Mydriatic (tropicamide and phenylephrine)
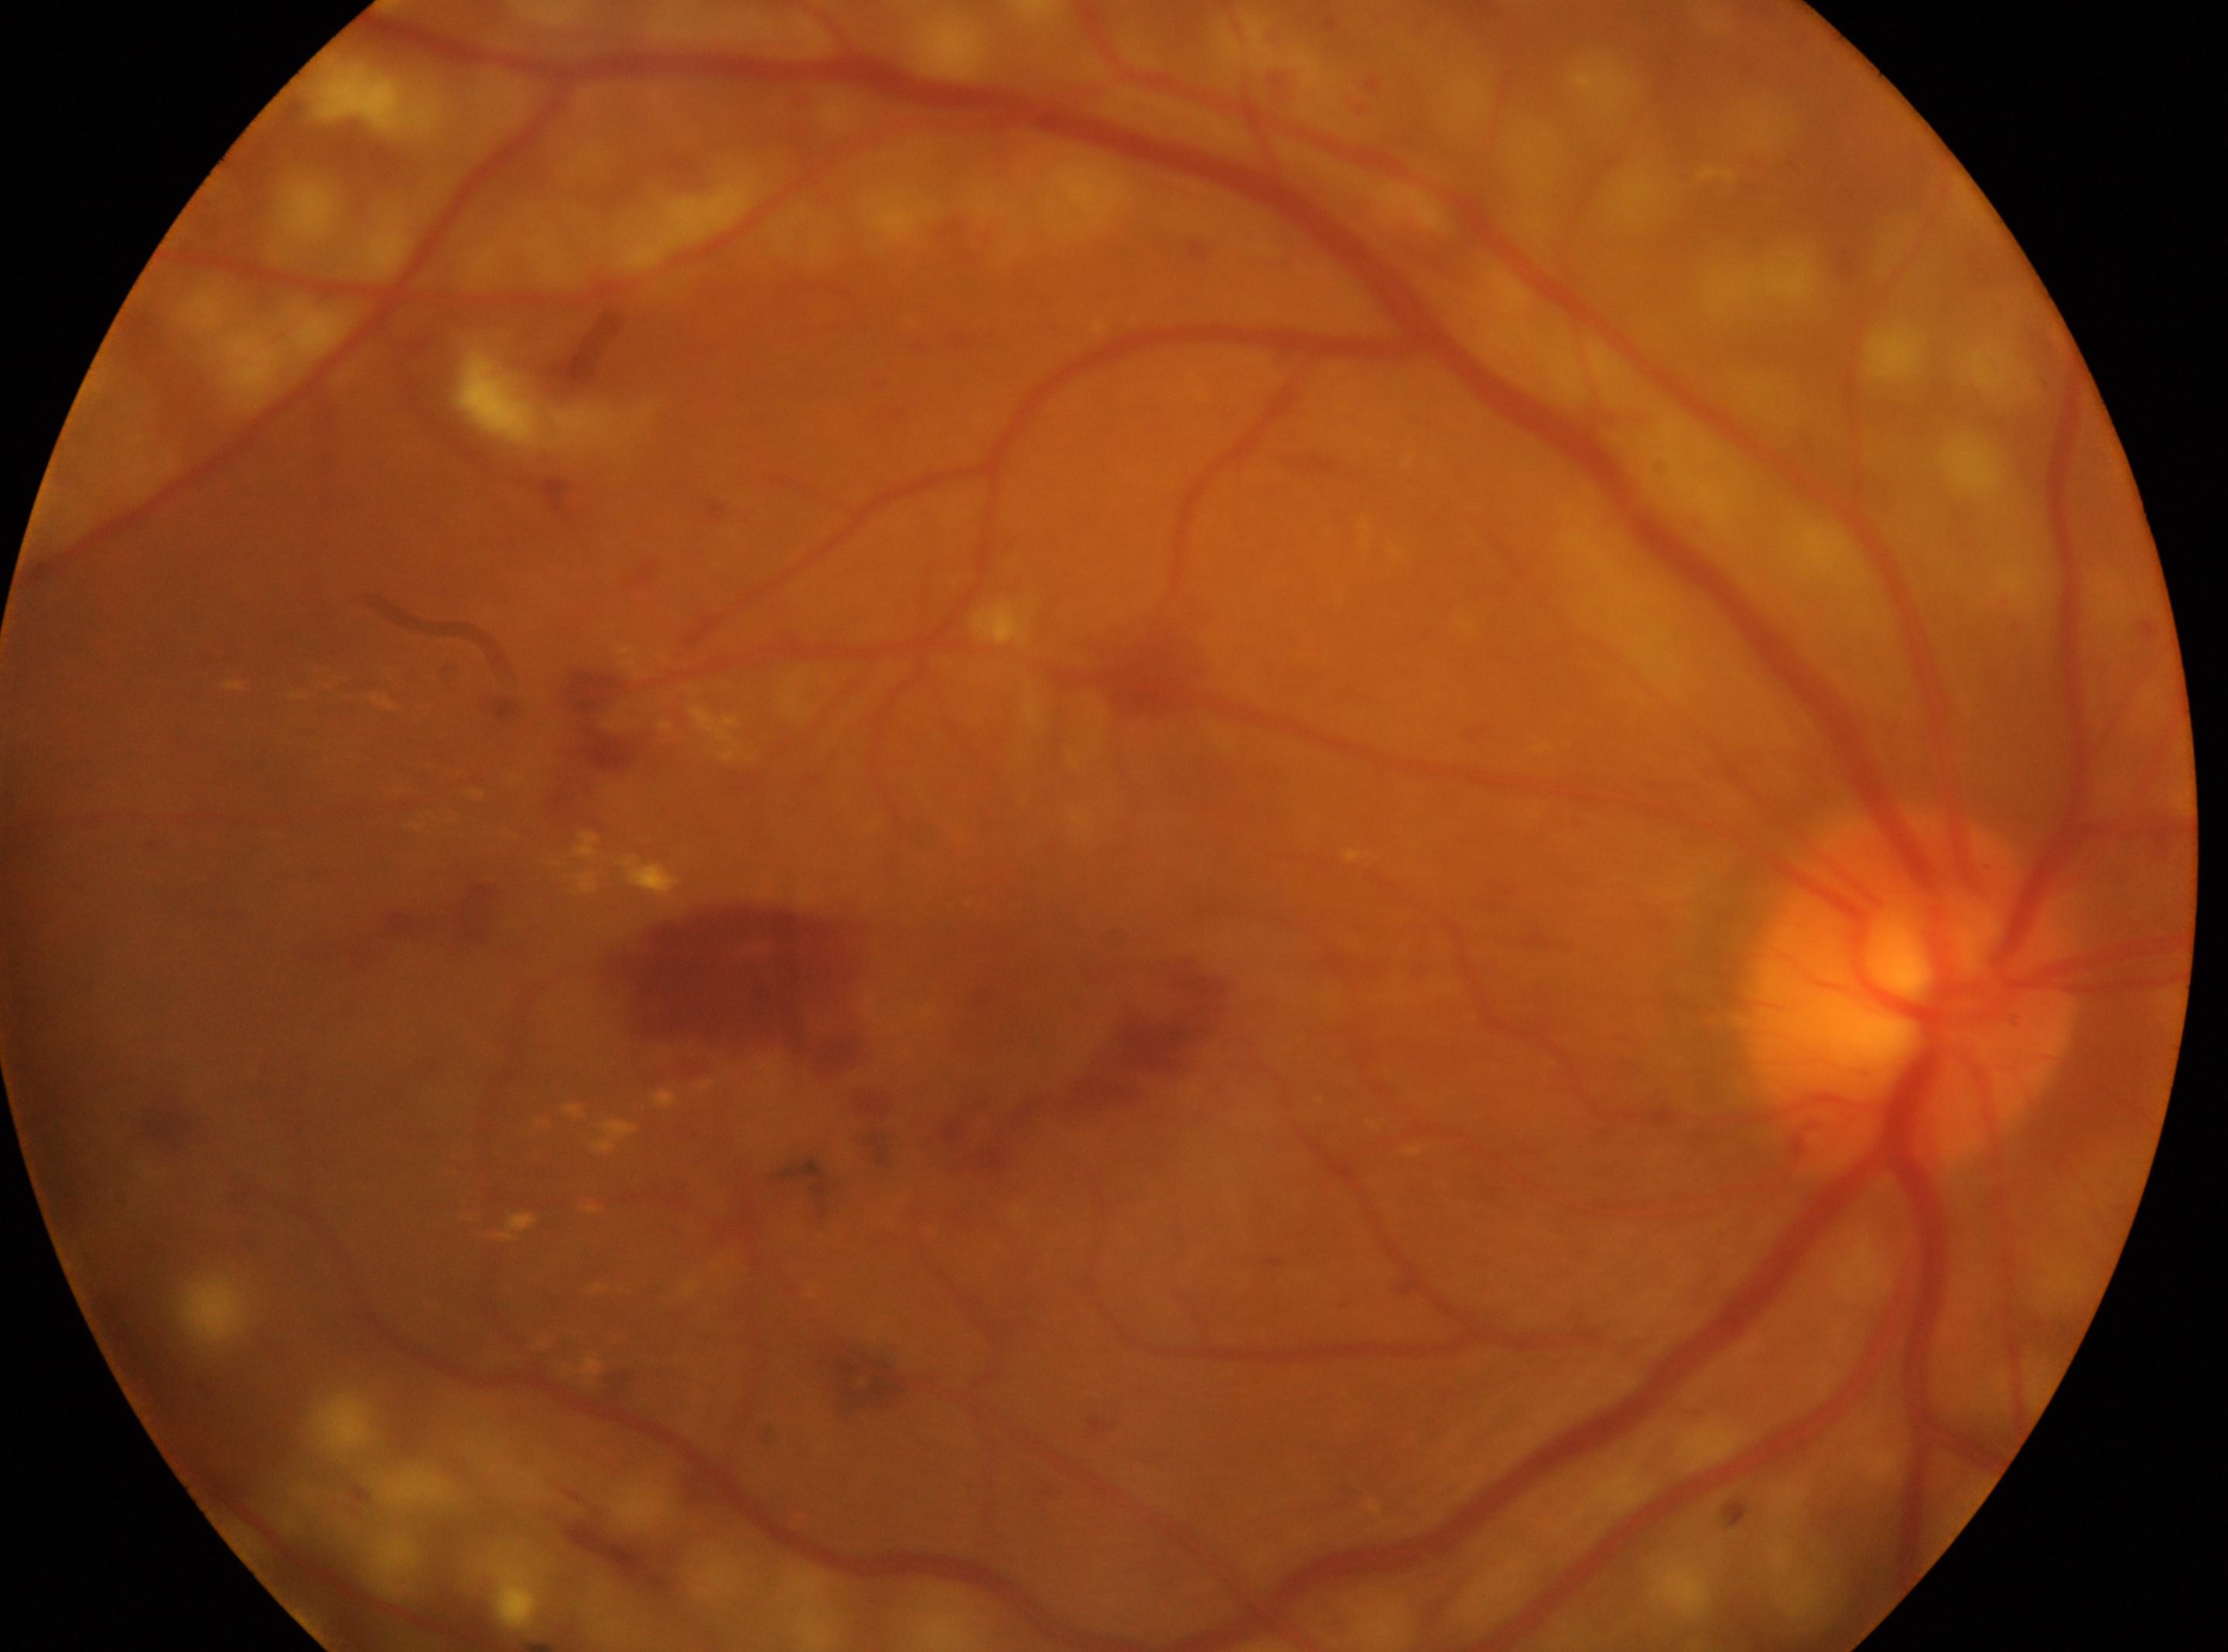

Diabetic retinopathy (DR): DR with laser photocoagulation scars — evidence of prior retinal laser photocoagulation (laser spots or scars). Disc center: (1904,988). The image shows the OD. Macula center located at (1017,976).